Color fundus photograph centered on the optic disc:
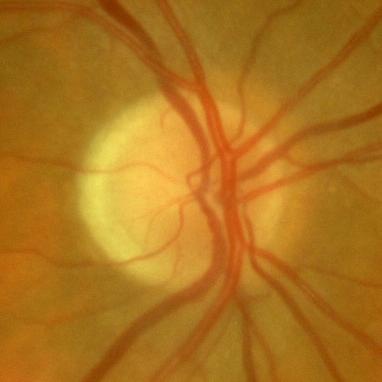
Glaucoma assessment: no evidence of glaucoma.